Infant wide-field retinal image. 640 by 480 pixels. 130° field of view (Clarity RetCam 3)
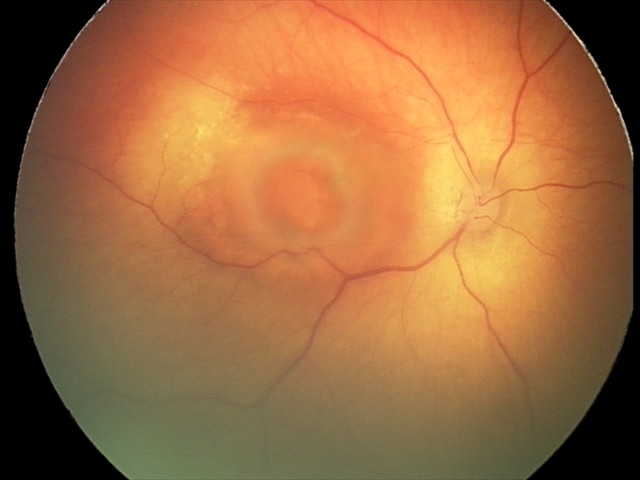

Screening: toxoplasmosis chorioretinitis.